FOV: 45 degrees; retinal fundus photograph
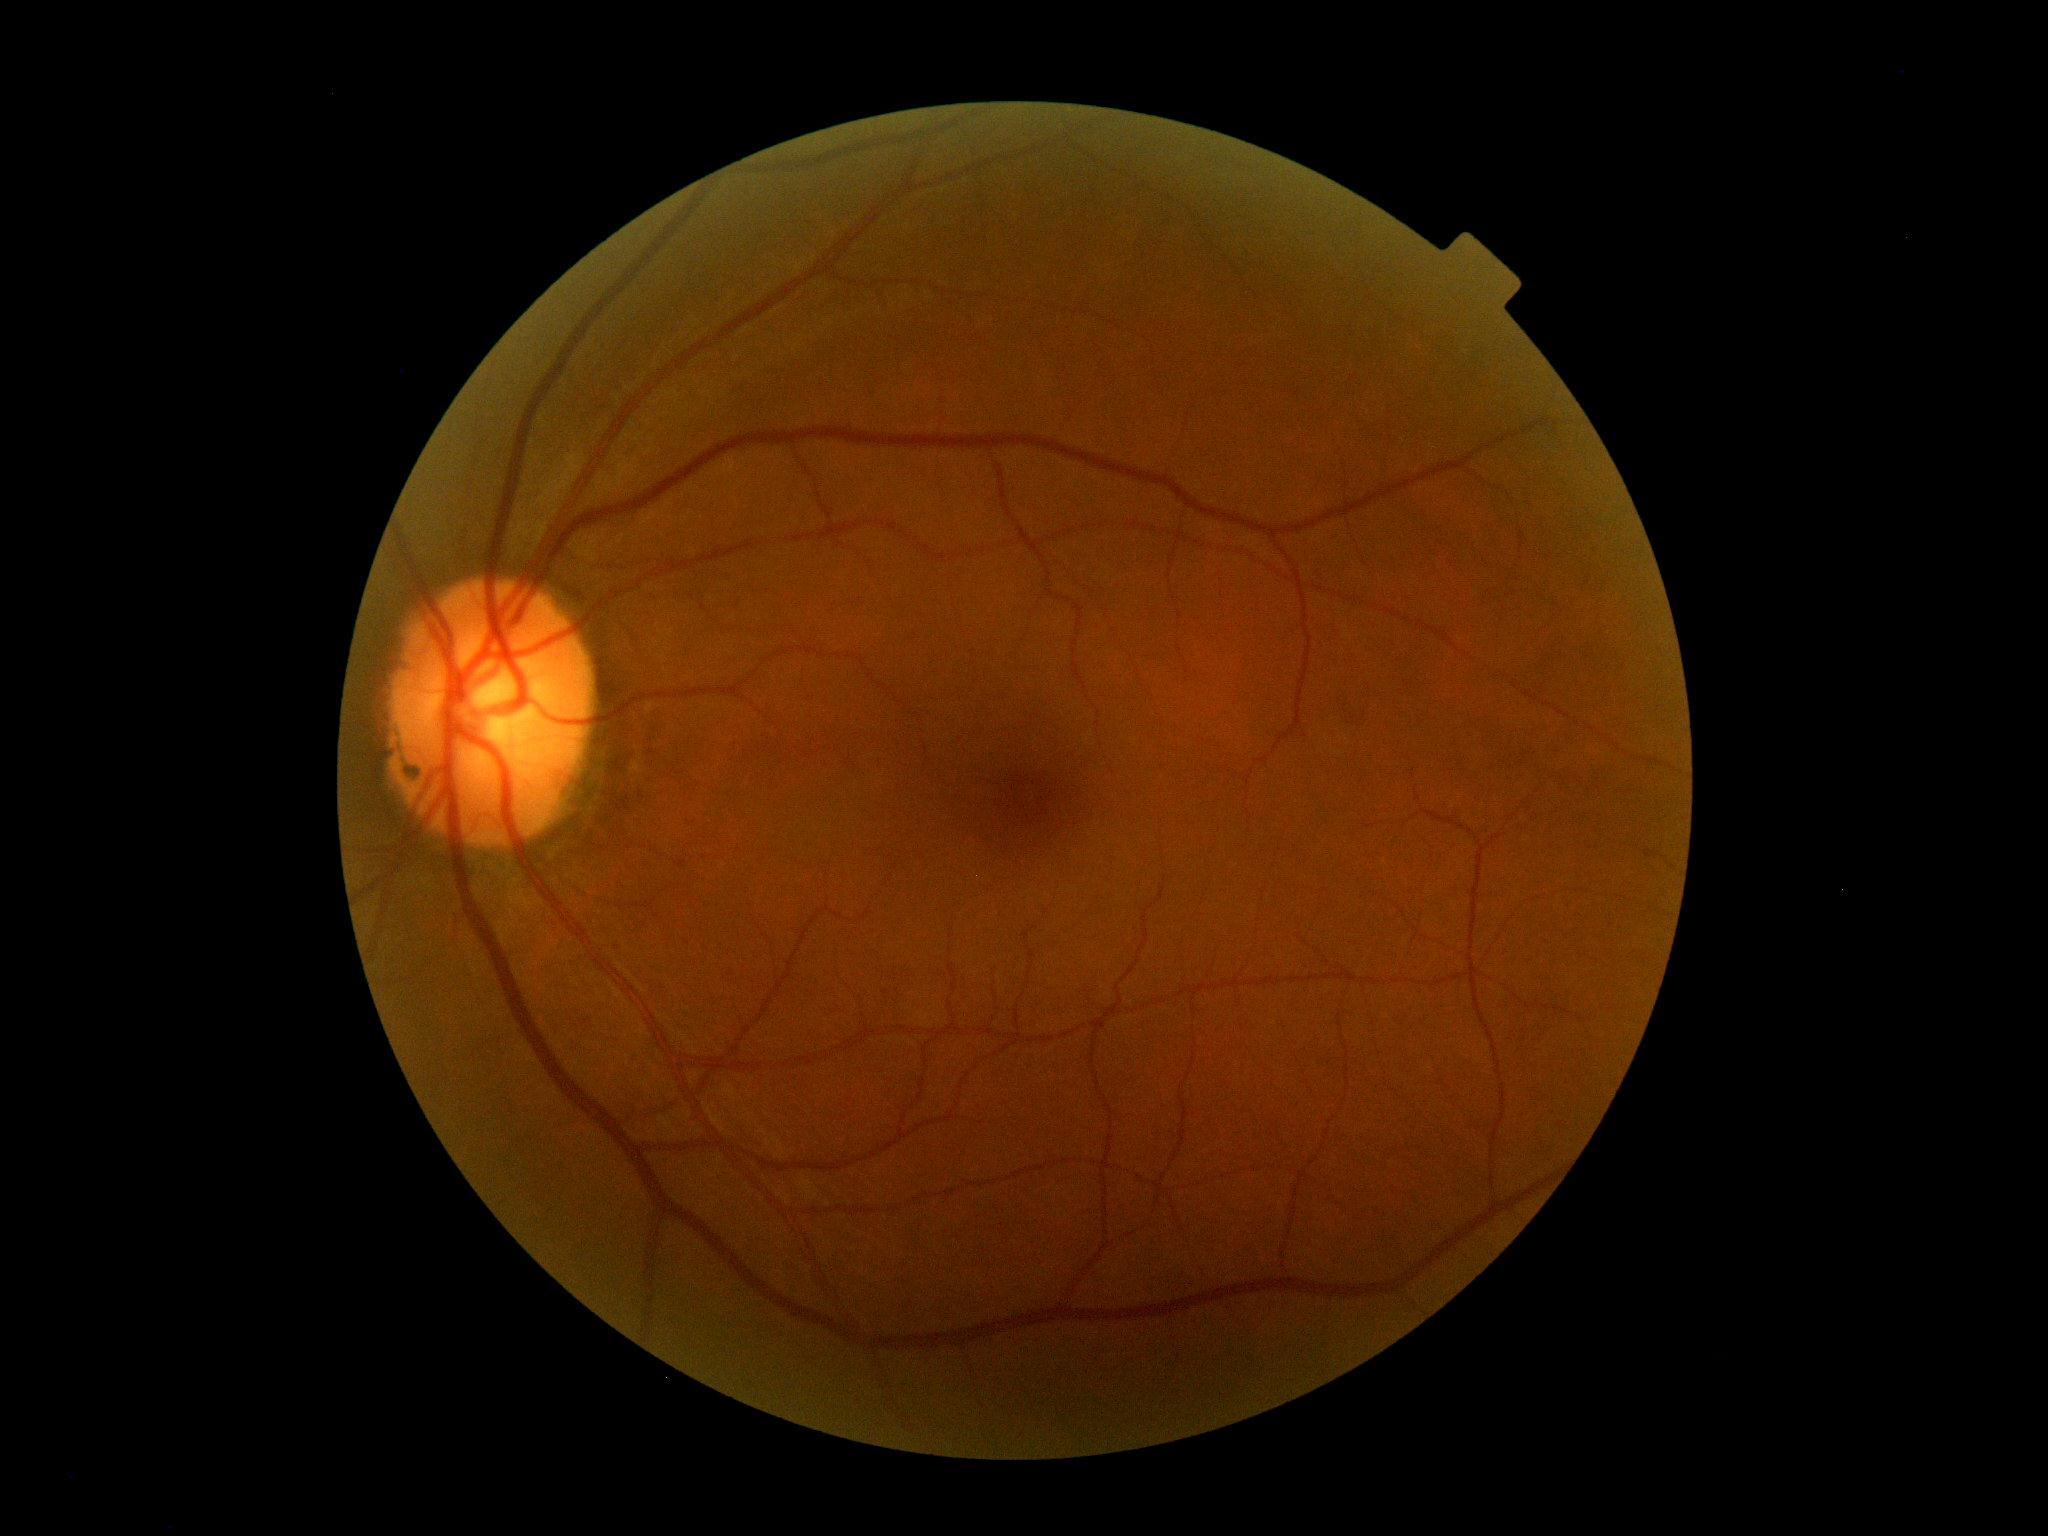

No apparent diabetic retinopathy. Retinopathy grade is 0.